Retinal fundus photograph · acquired with a NIDEK AFC-230: 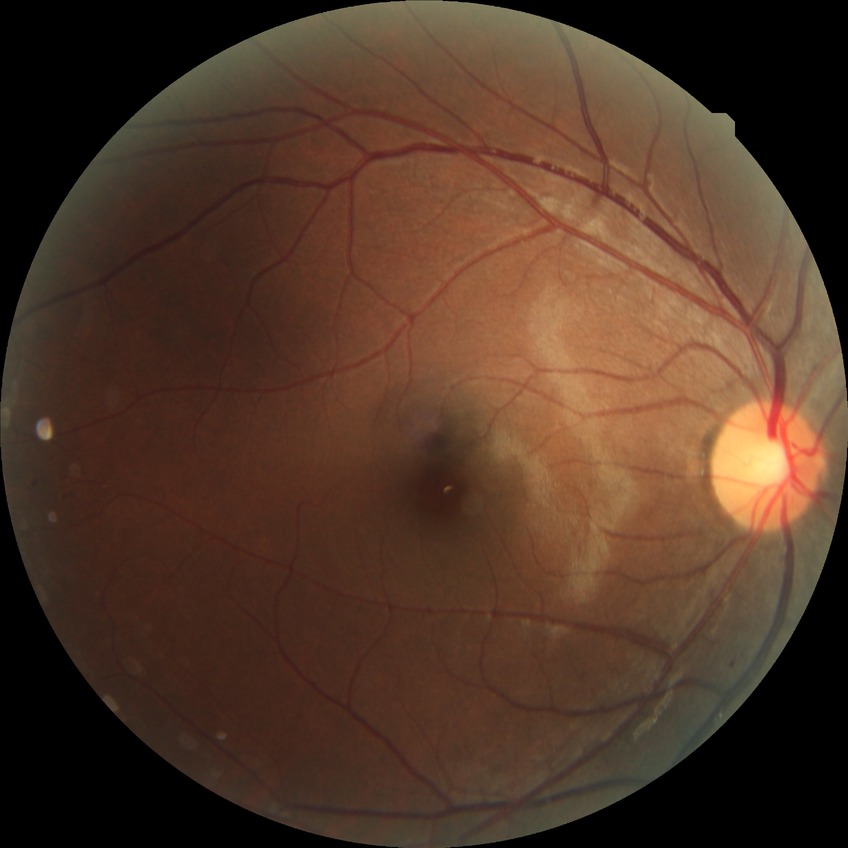

Findings:
– DR class — non-proliferative diabetic retinopathy
– diabetic retinopathy (DR) — simple diabetic retinopathy (SDR)